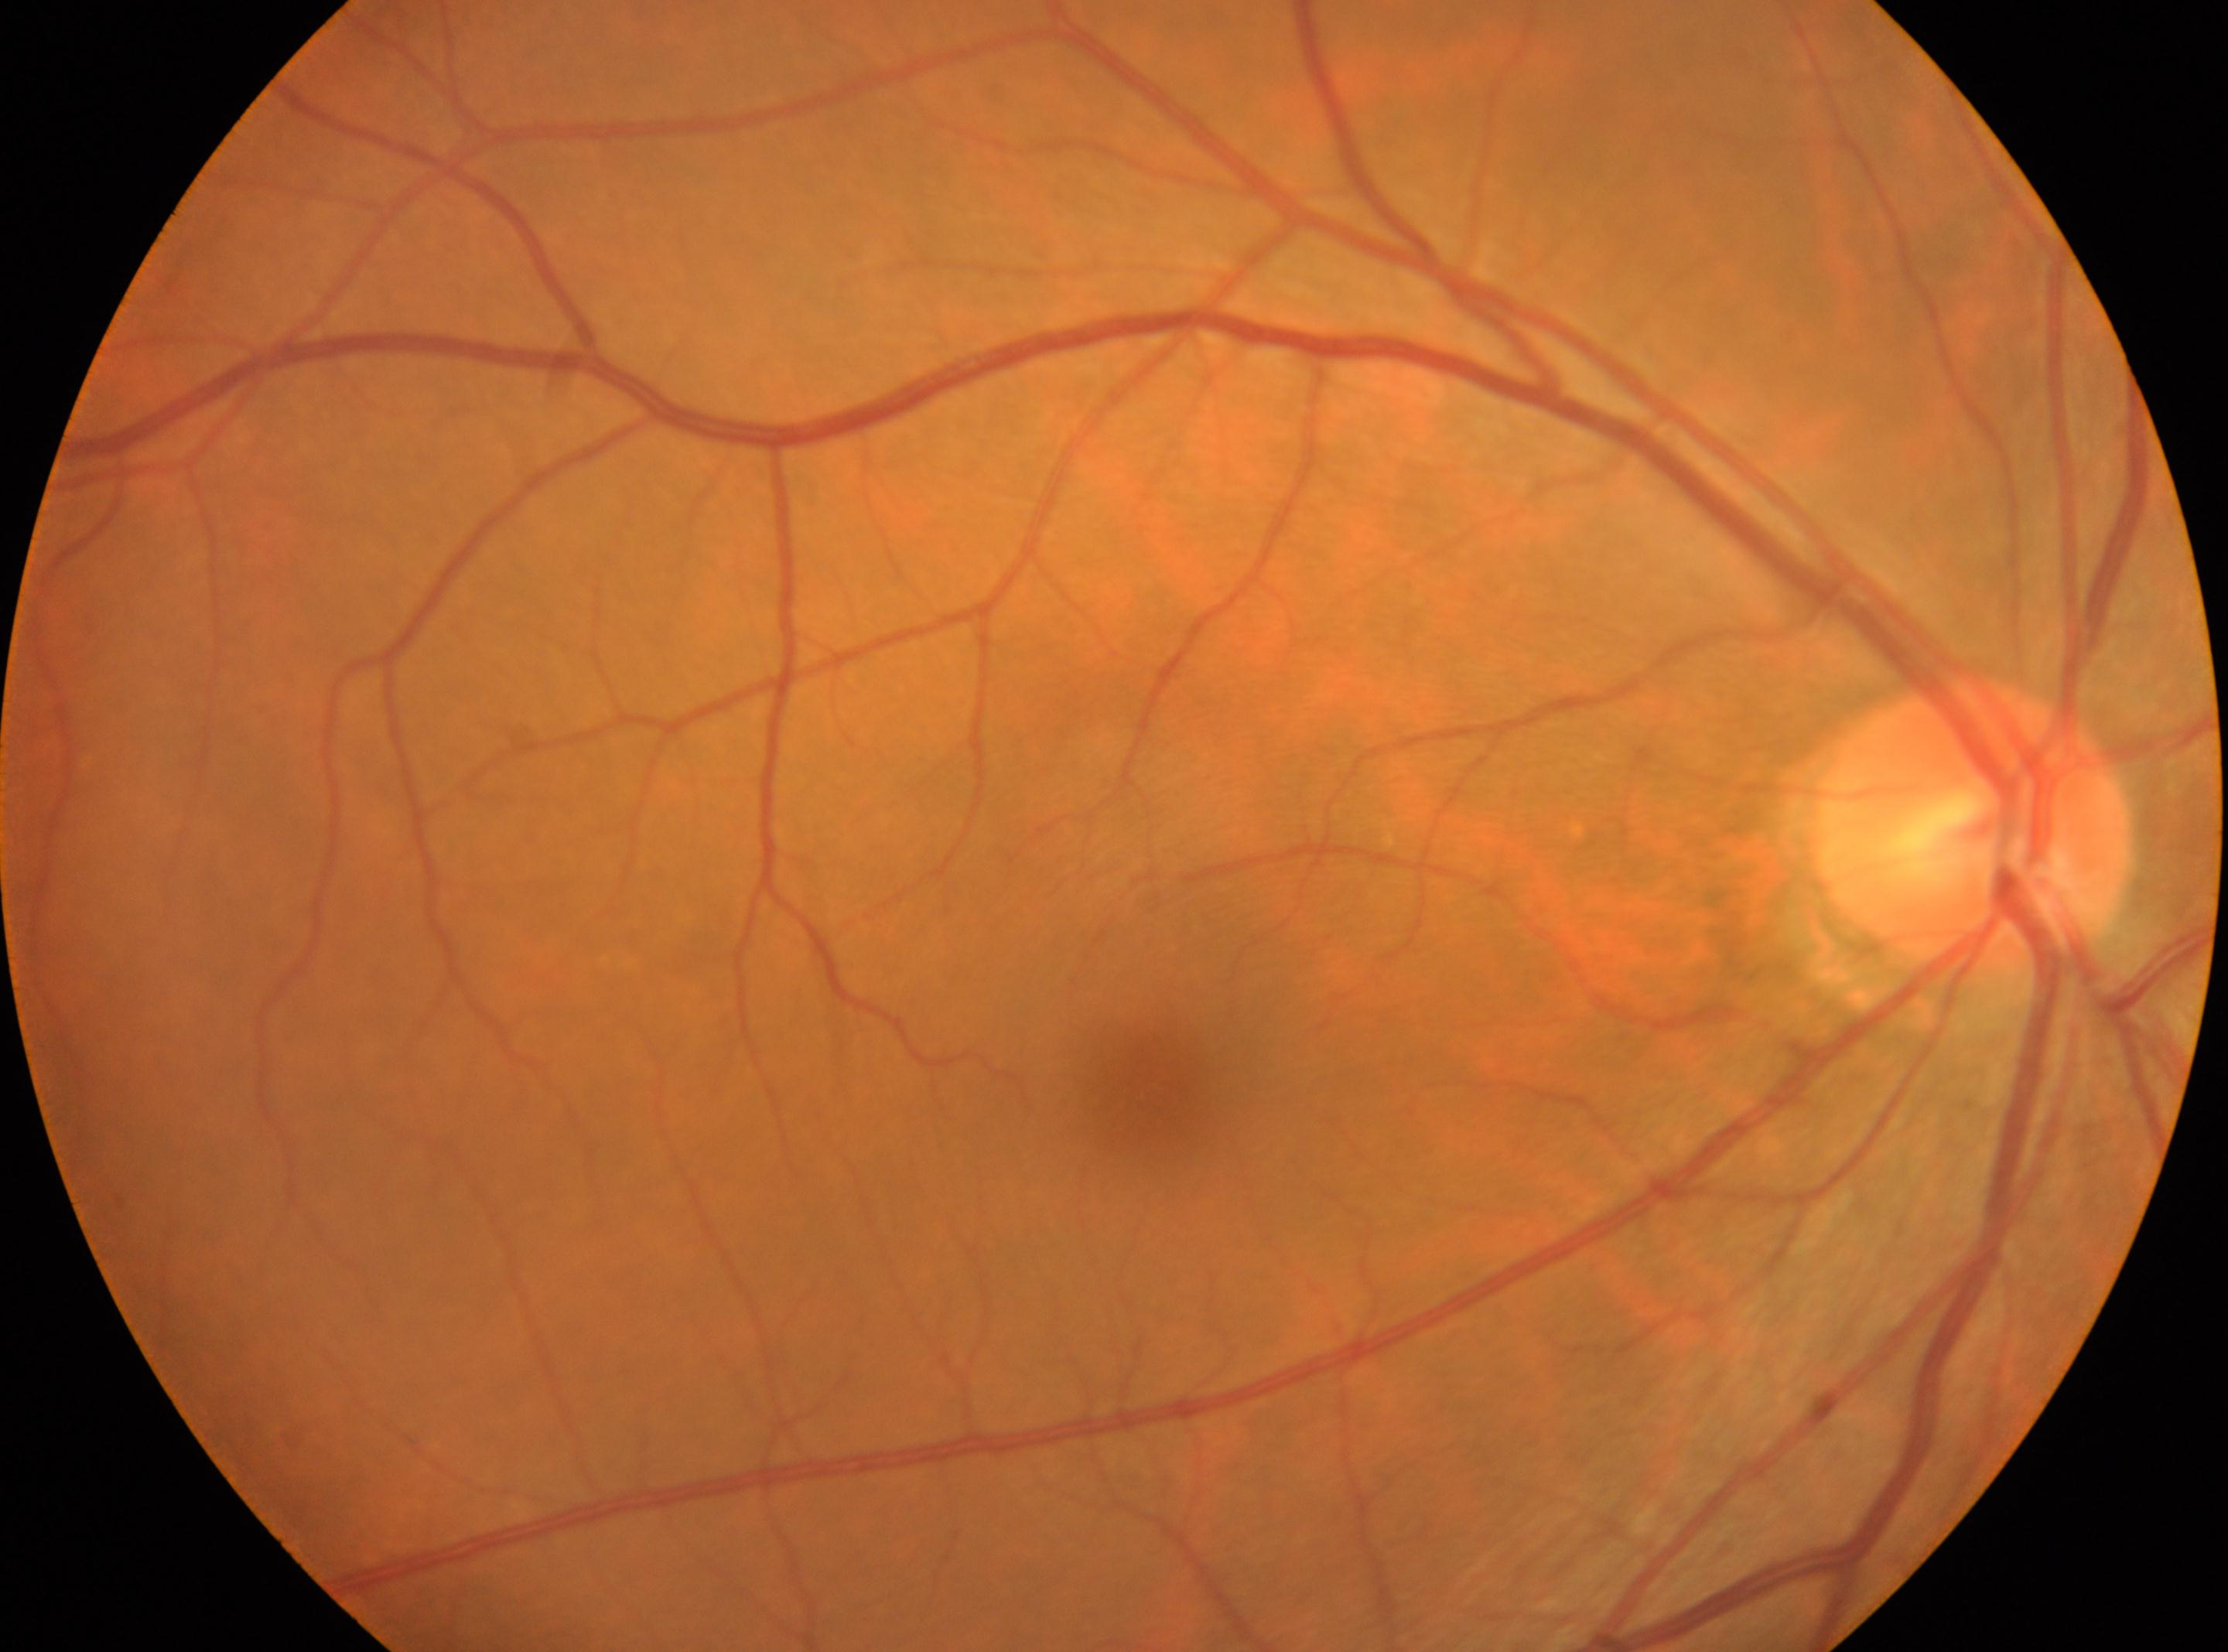
DR is no apparent diabetic retinopathy (grade 0). Imaged eye: right. Fovea center located at (x=1148, y=1089). ONH: (x=1973, y=821).